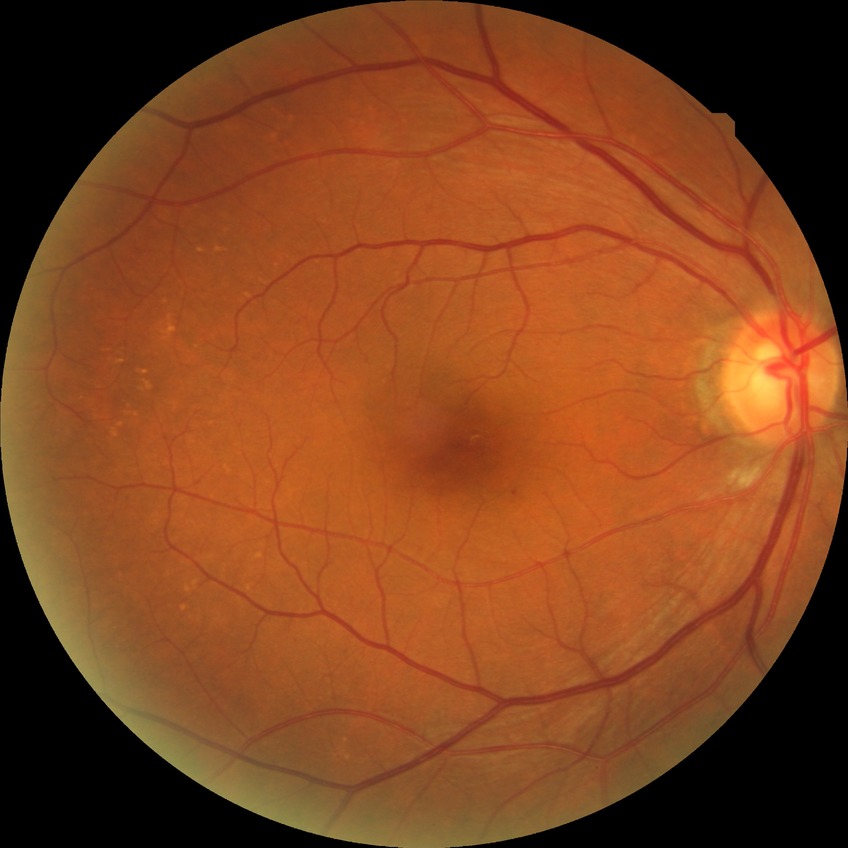

The retinopathy is classified as non-proliferative diabetic retinopathy.
DR severity: SDR.